RetCam wide-field infant fundus image. Captured with the Clarity RetCam 3 (130° field of view)
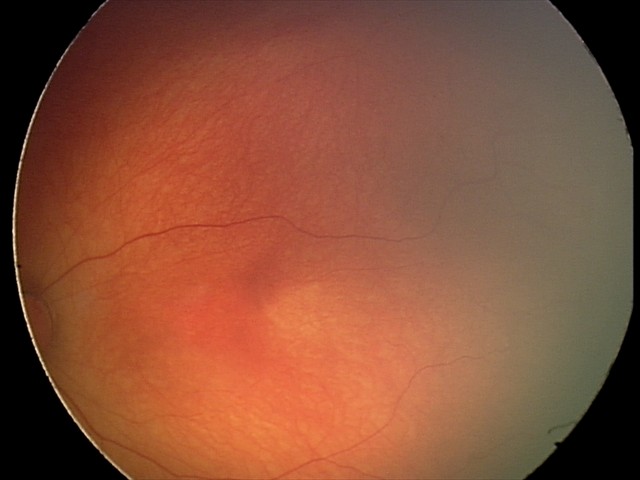
Screening: physiological retinal finding.